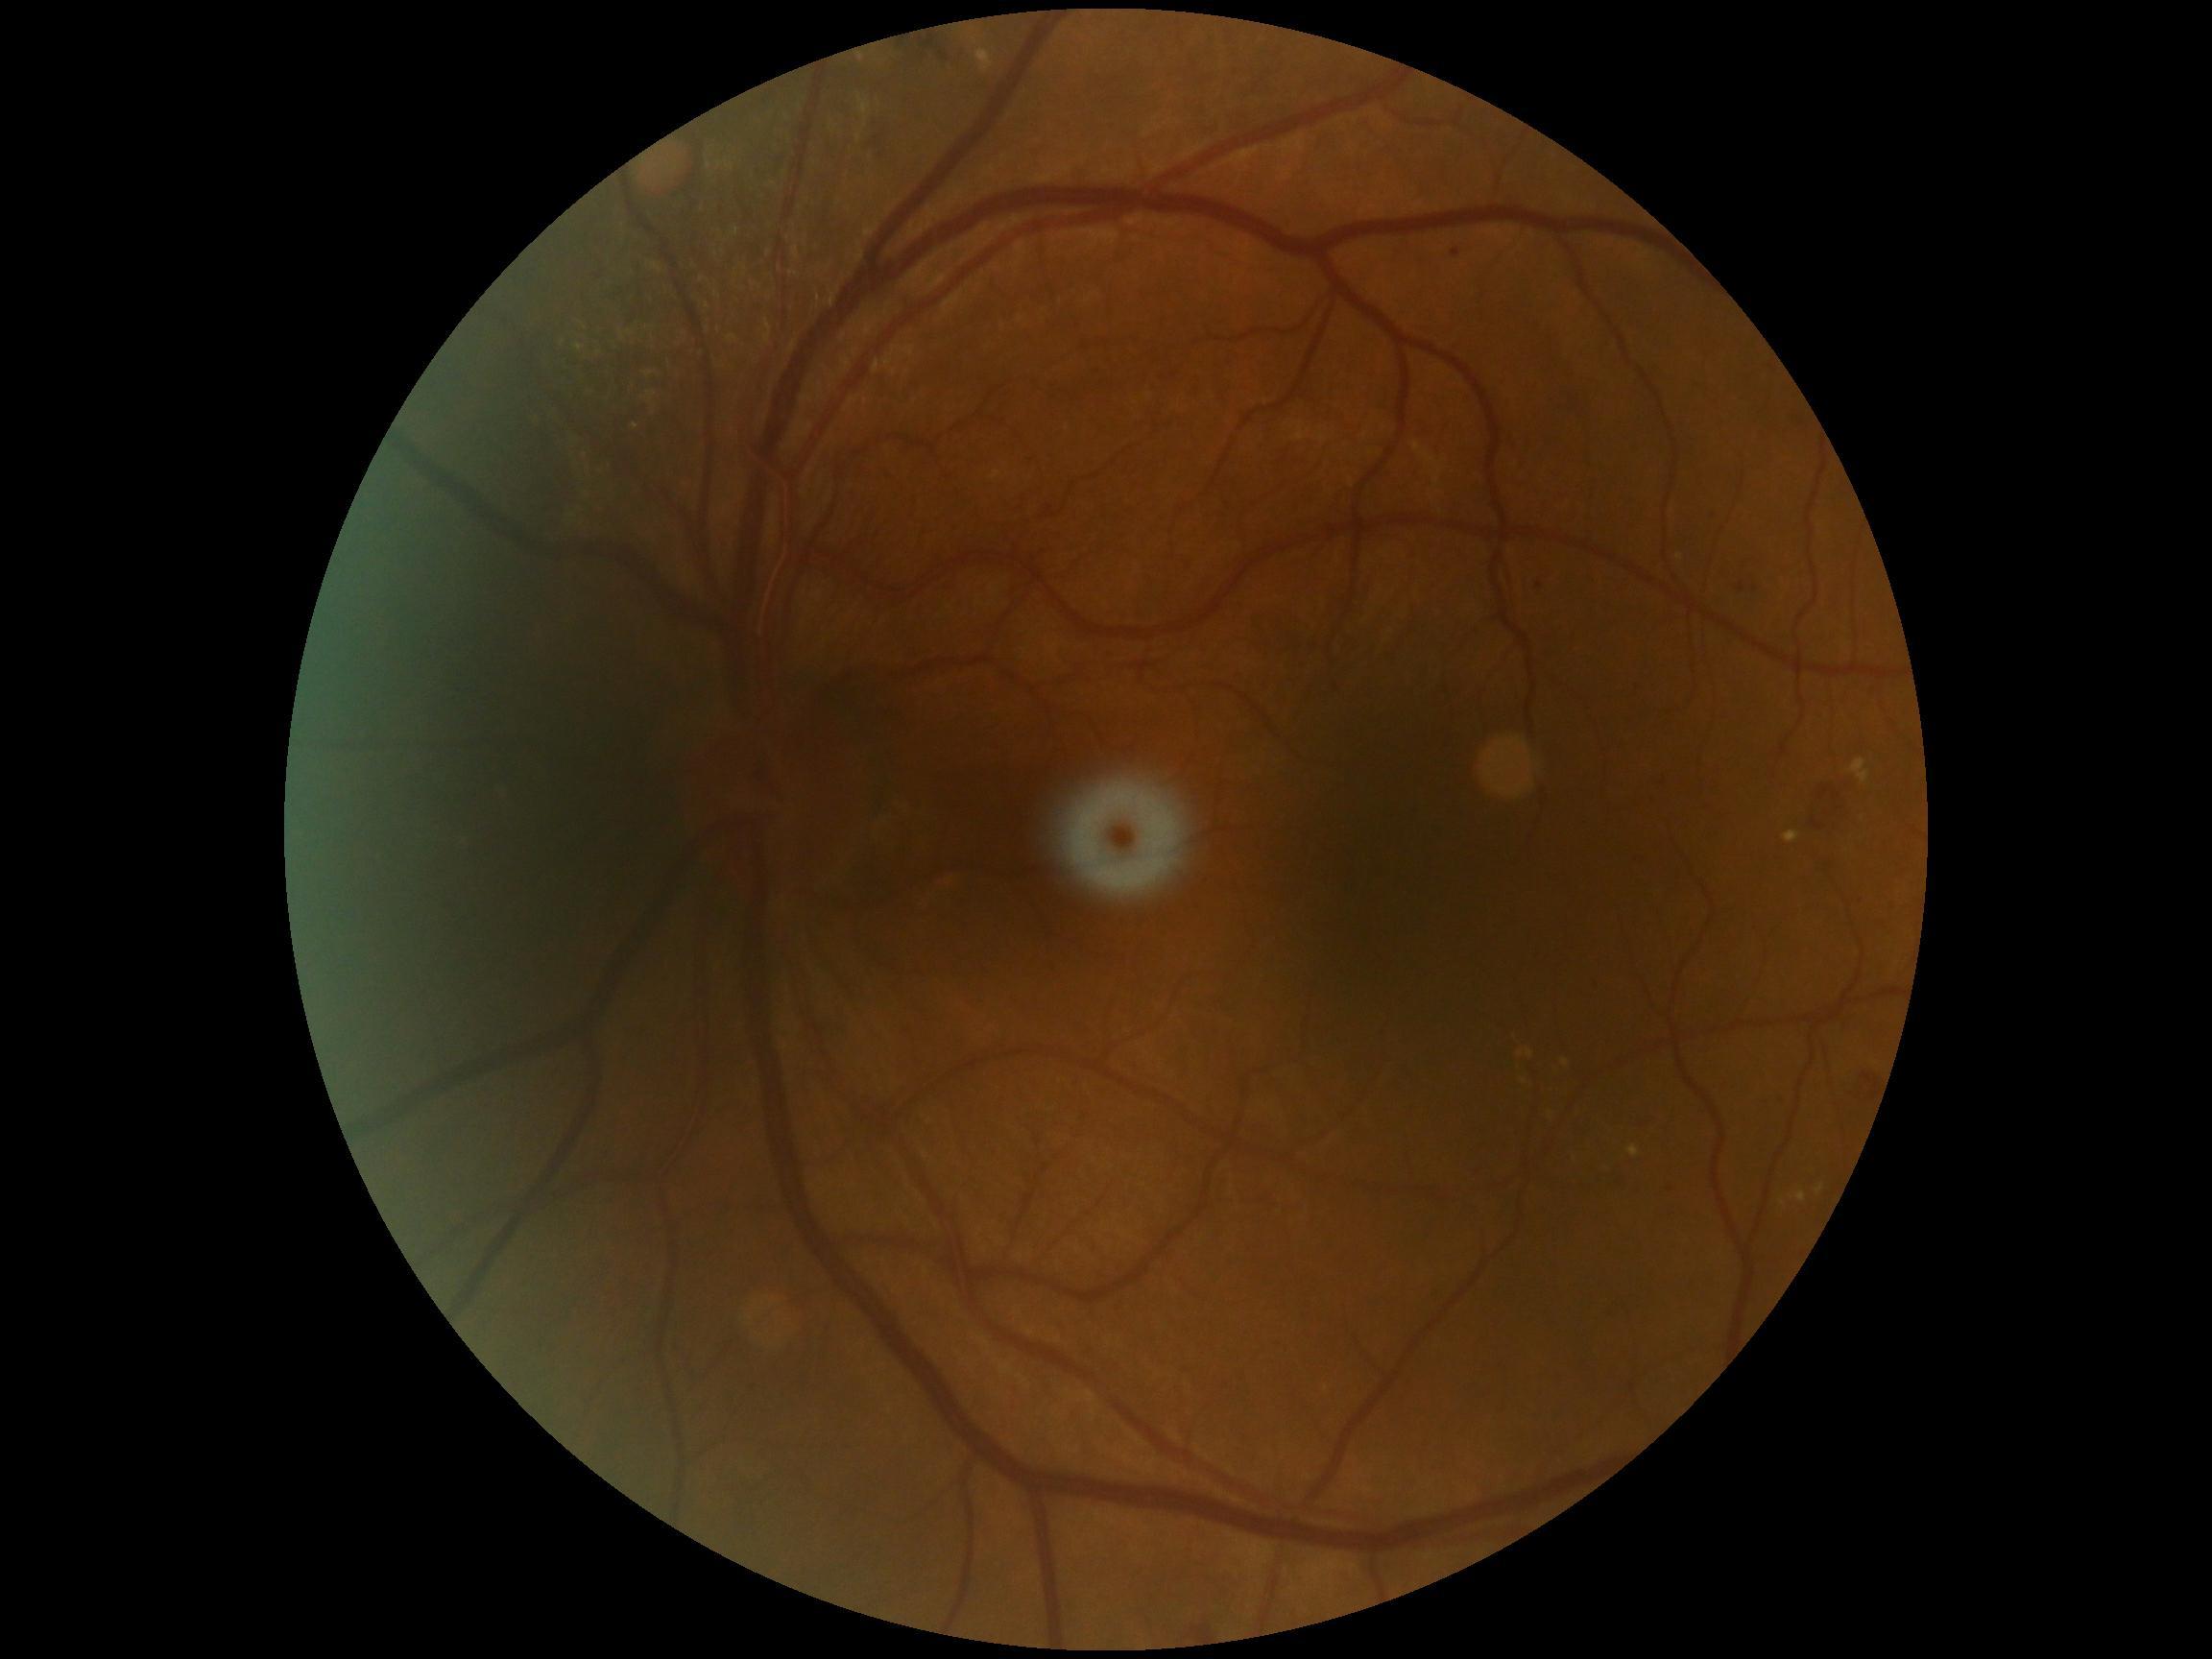 DR grade=moderate non-proliferative diabetic retinopathy (2).